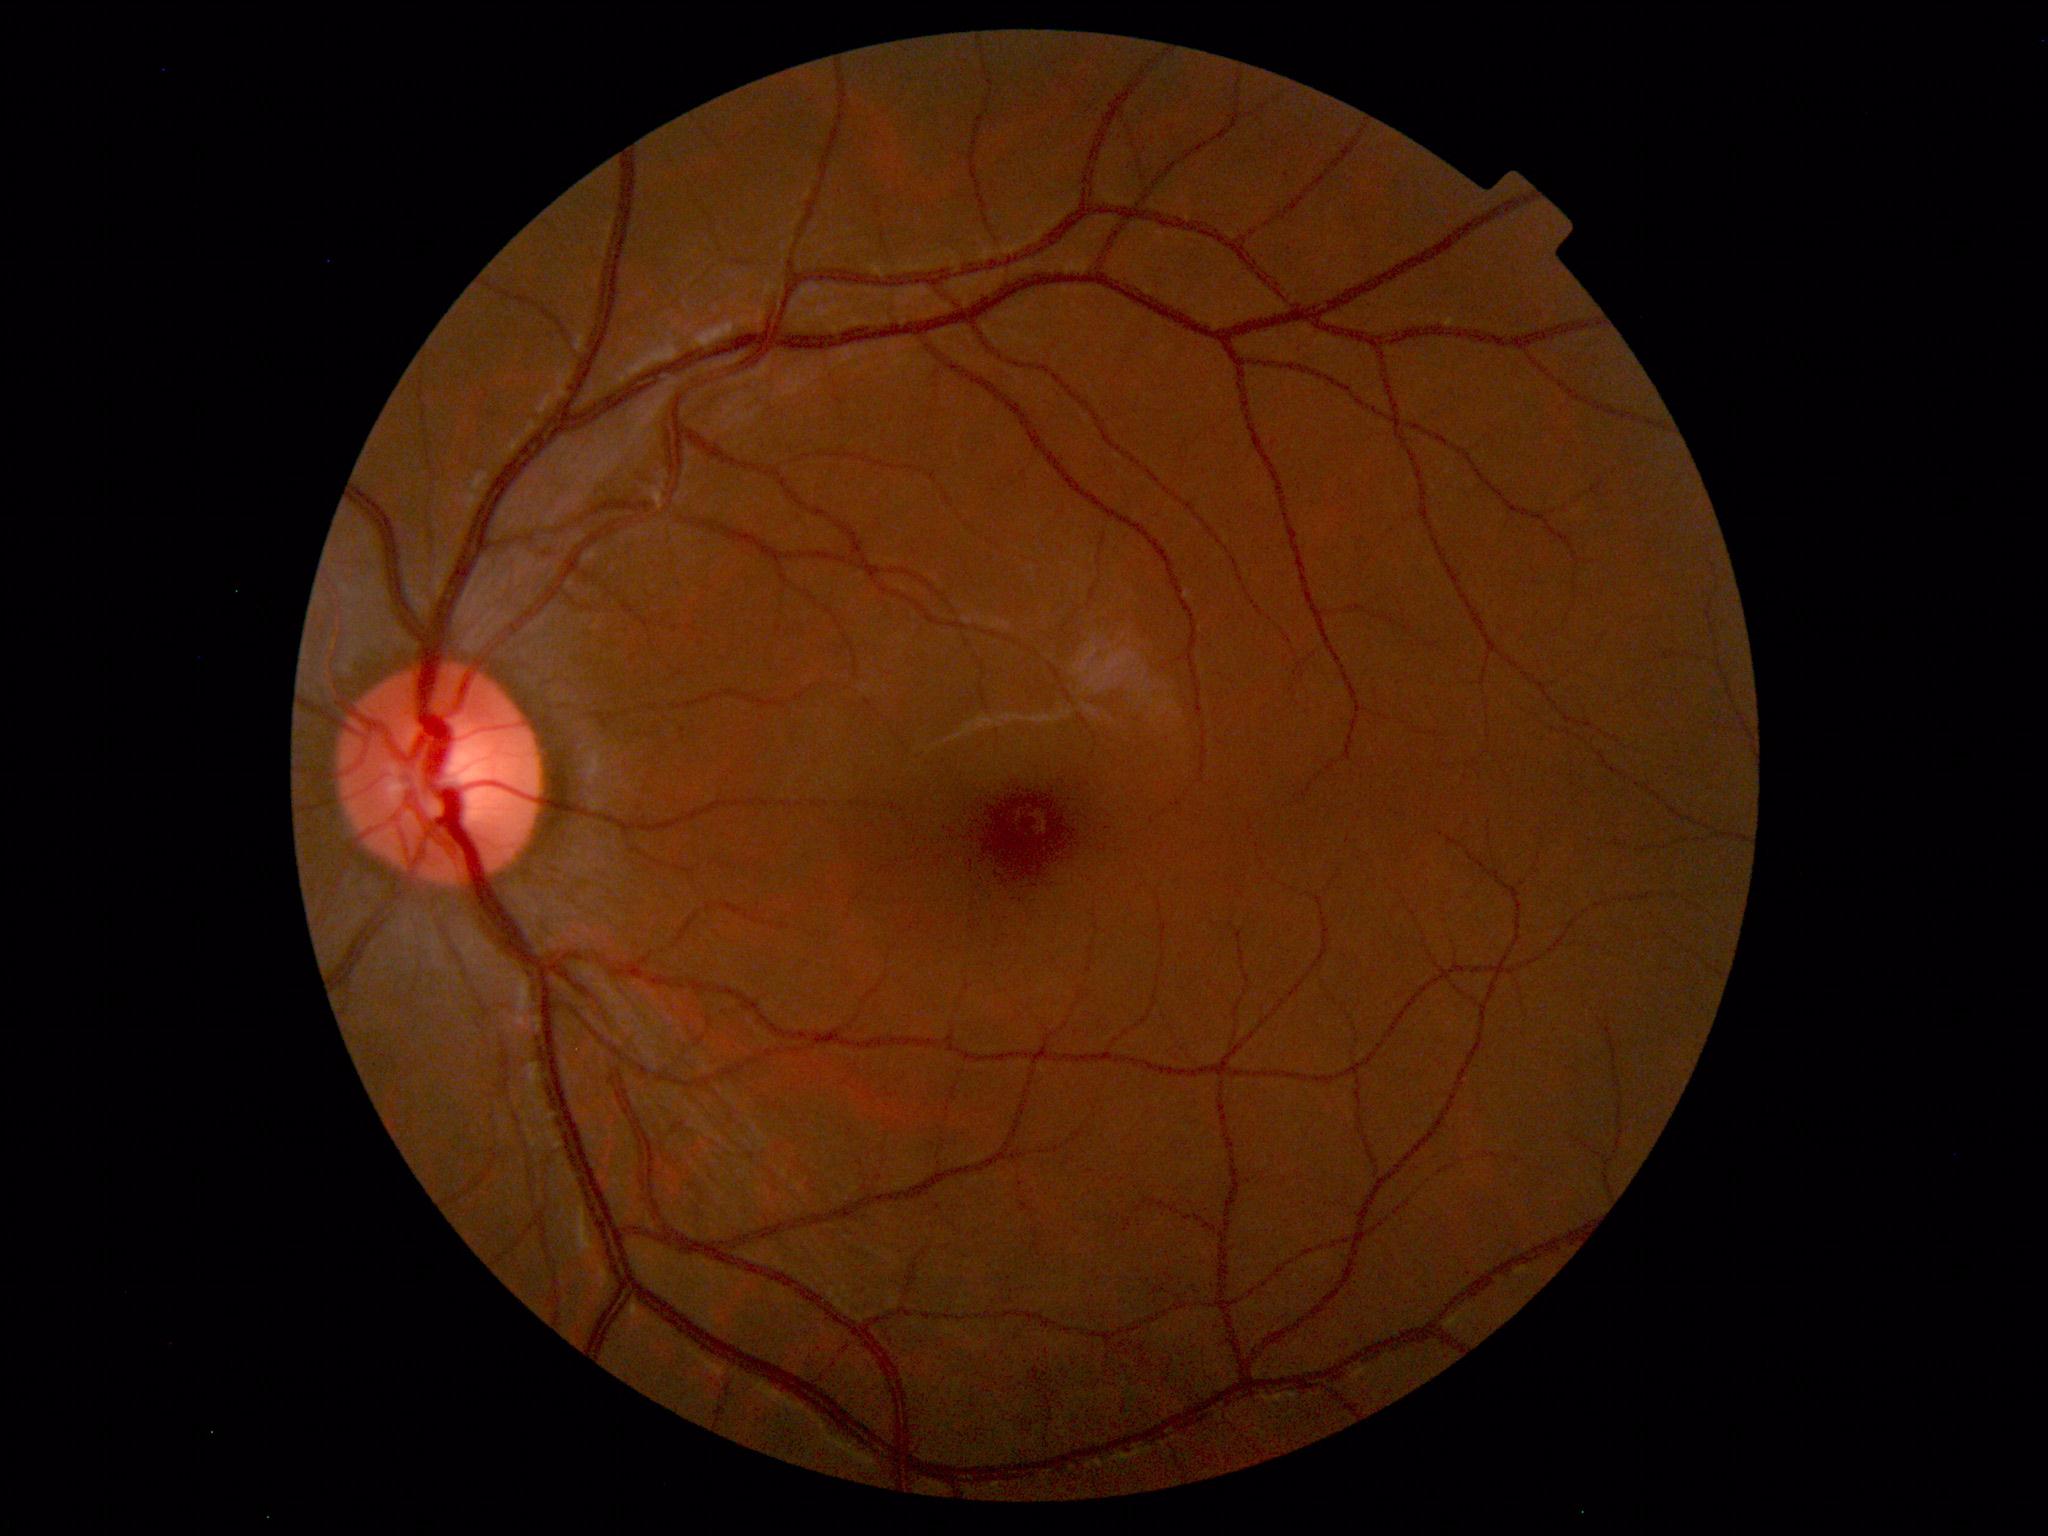 Diagnosis: normal.